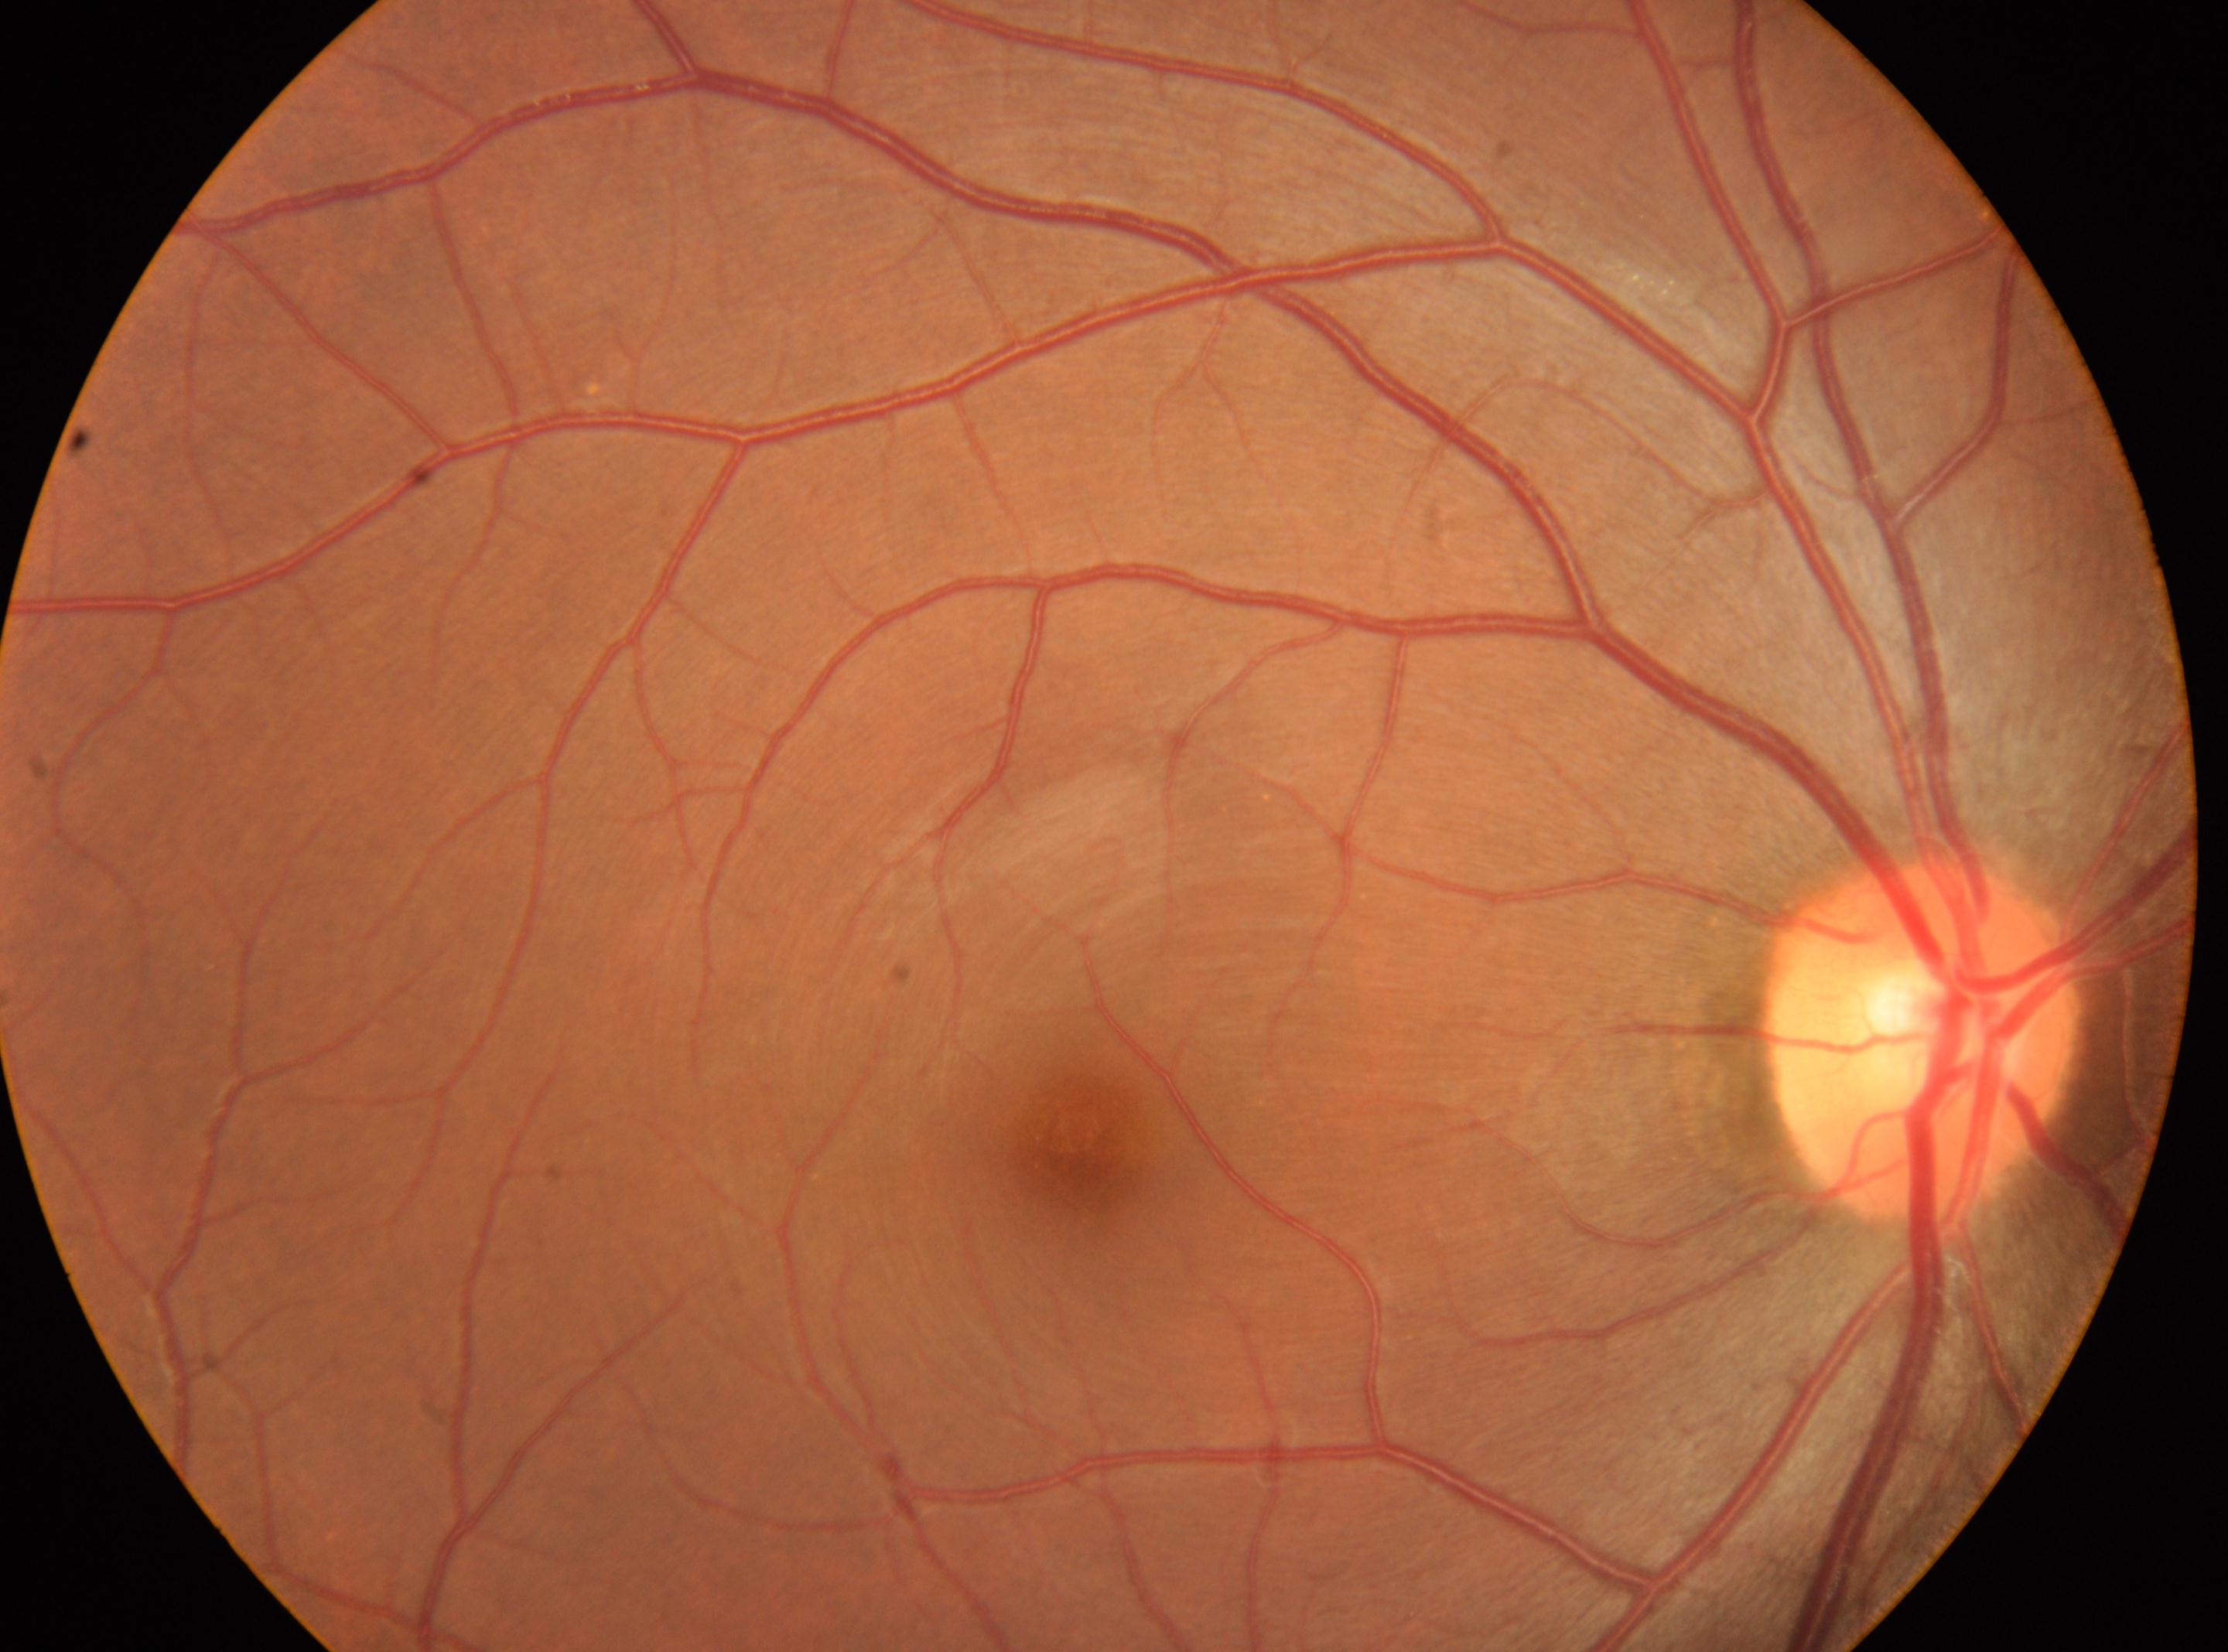 This is the oculus dexter.
ONH located at (x: 1922, y: 1043).
DR severity is 0.
Foveal center: (x: 1075, y: 1137).